Nidek AFC-330 · captured without pupil dilation · color fundus image:
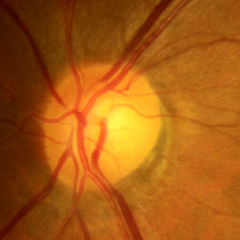
Glaucoma stage = no evidence of glaucoma.